1240 x 1240 pixels. Phoenix ICON wide-field infant fundus image: 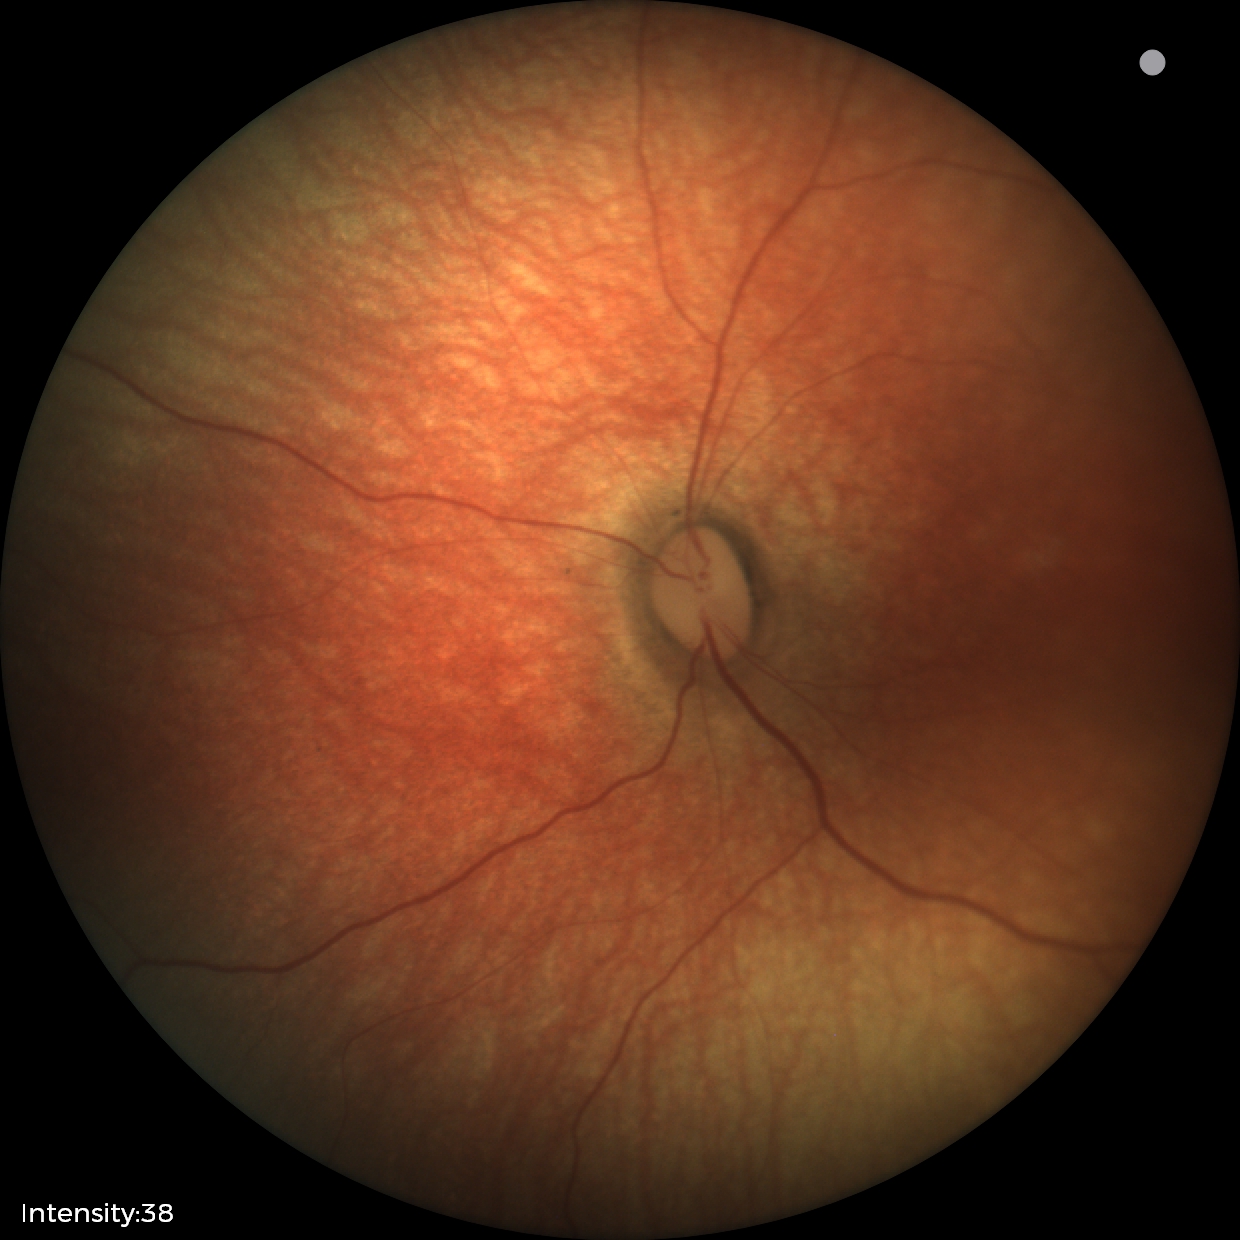 Assessment: physiological.